Graded on the modified Davis scale · nonmydriatic fundus photograph · image size 848x848 · posterior pole color fundus photograph:
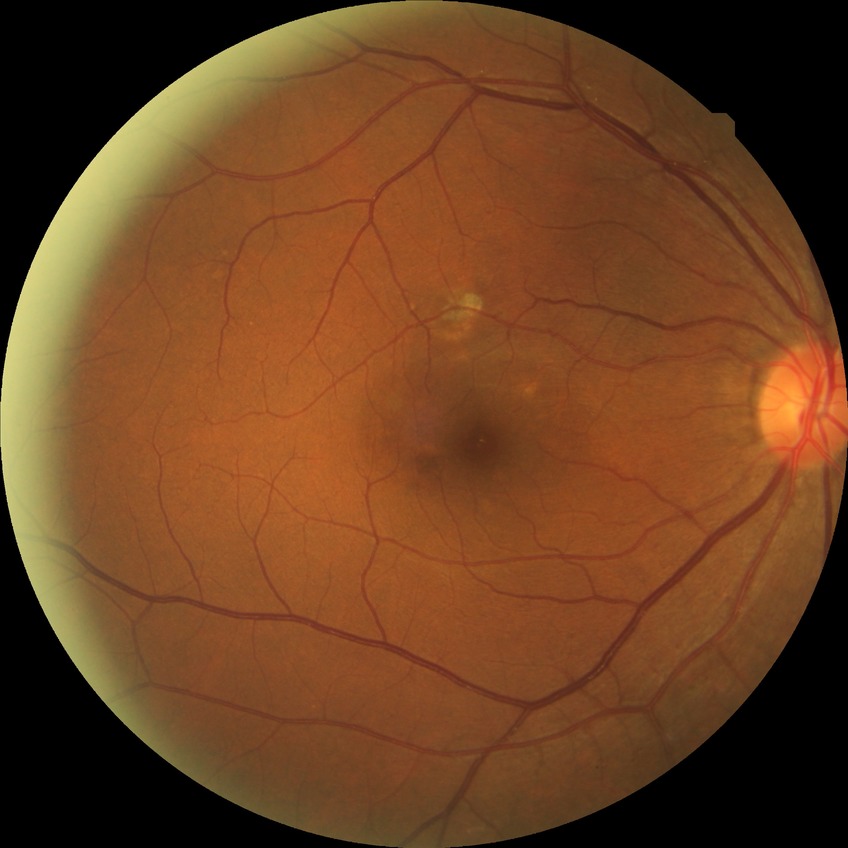
diabetic retinopathy (DR) = NDR (no diabetic retinopathy).